Image size 2102x1736.
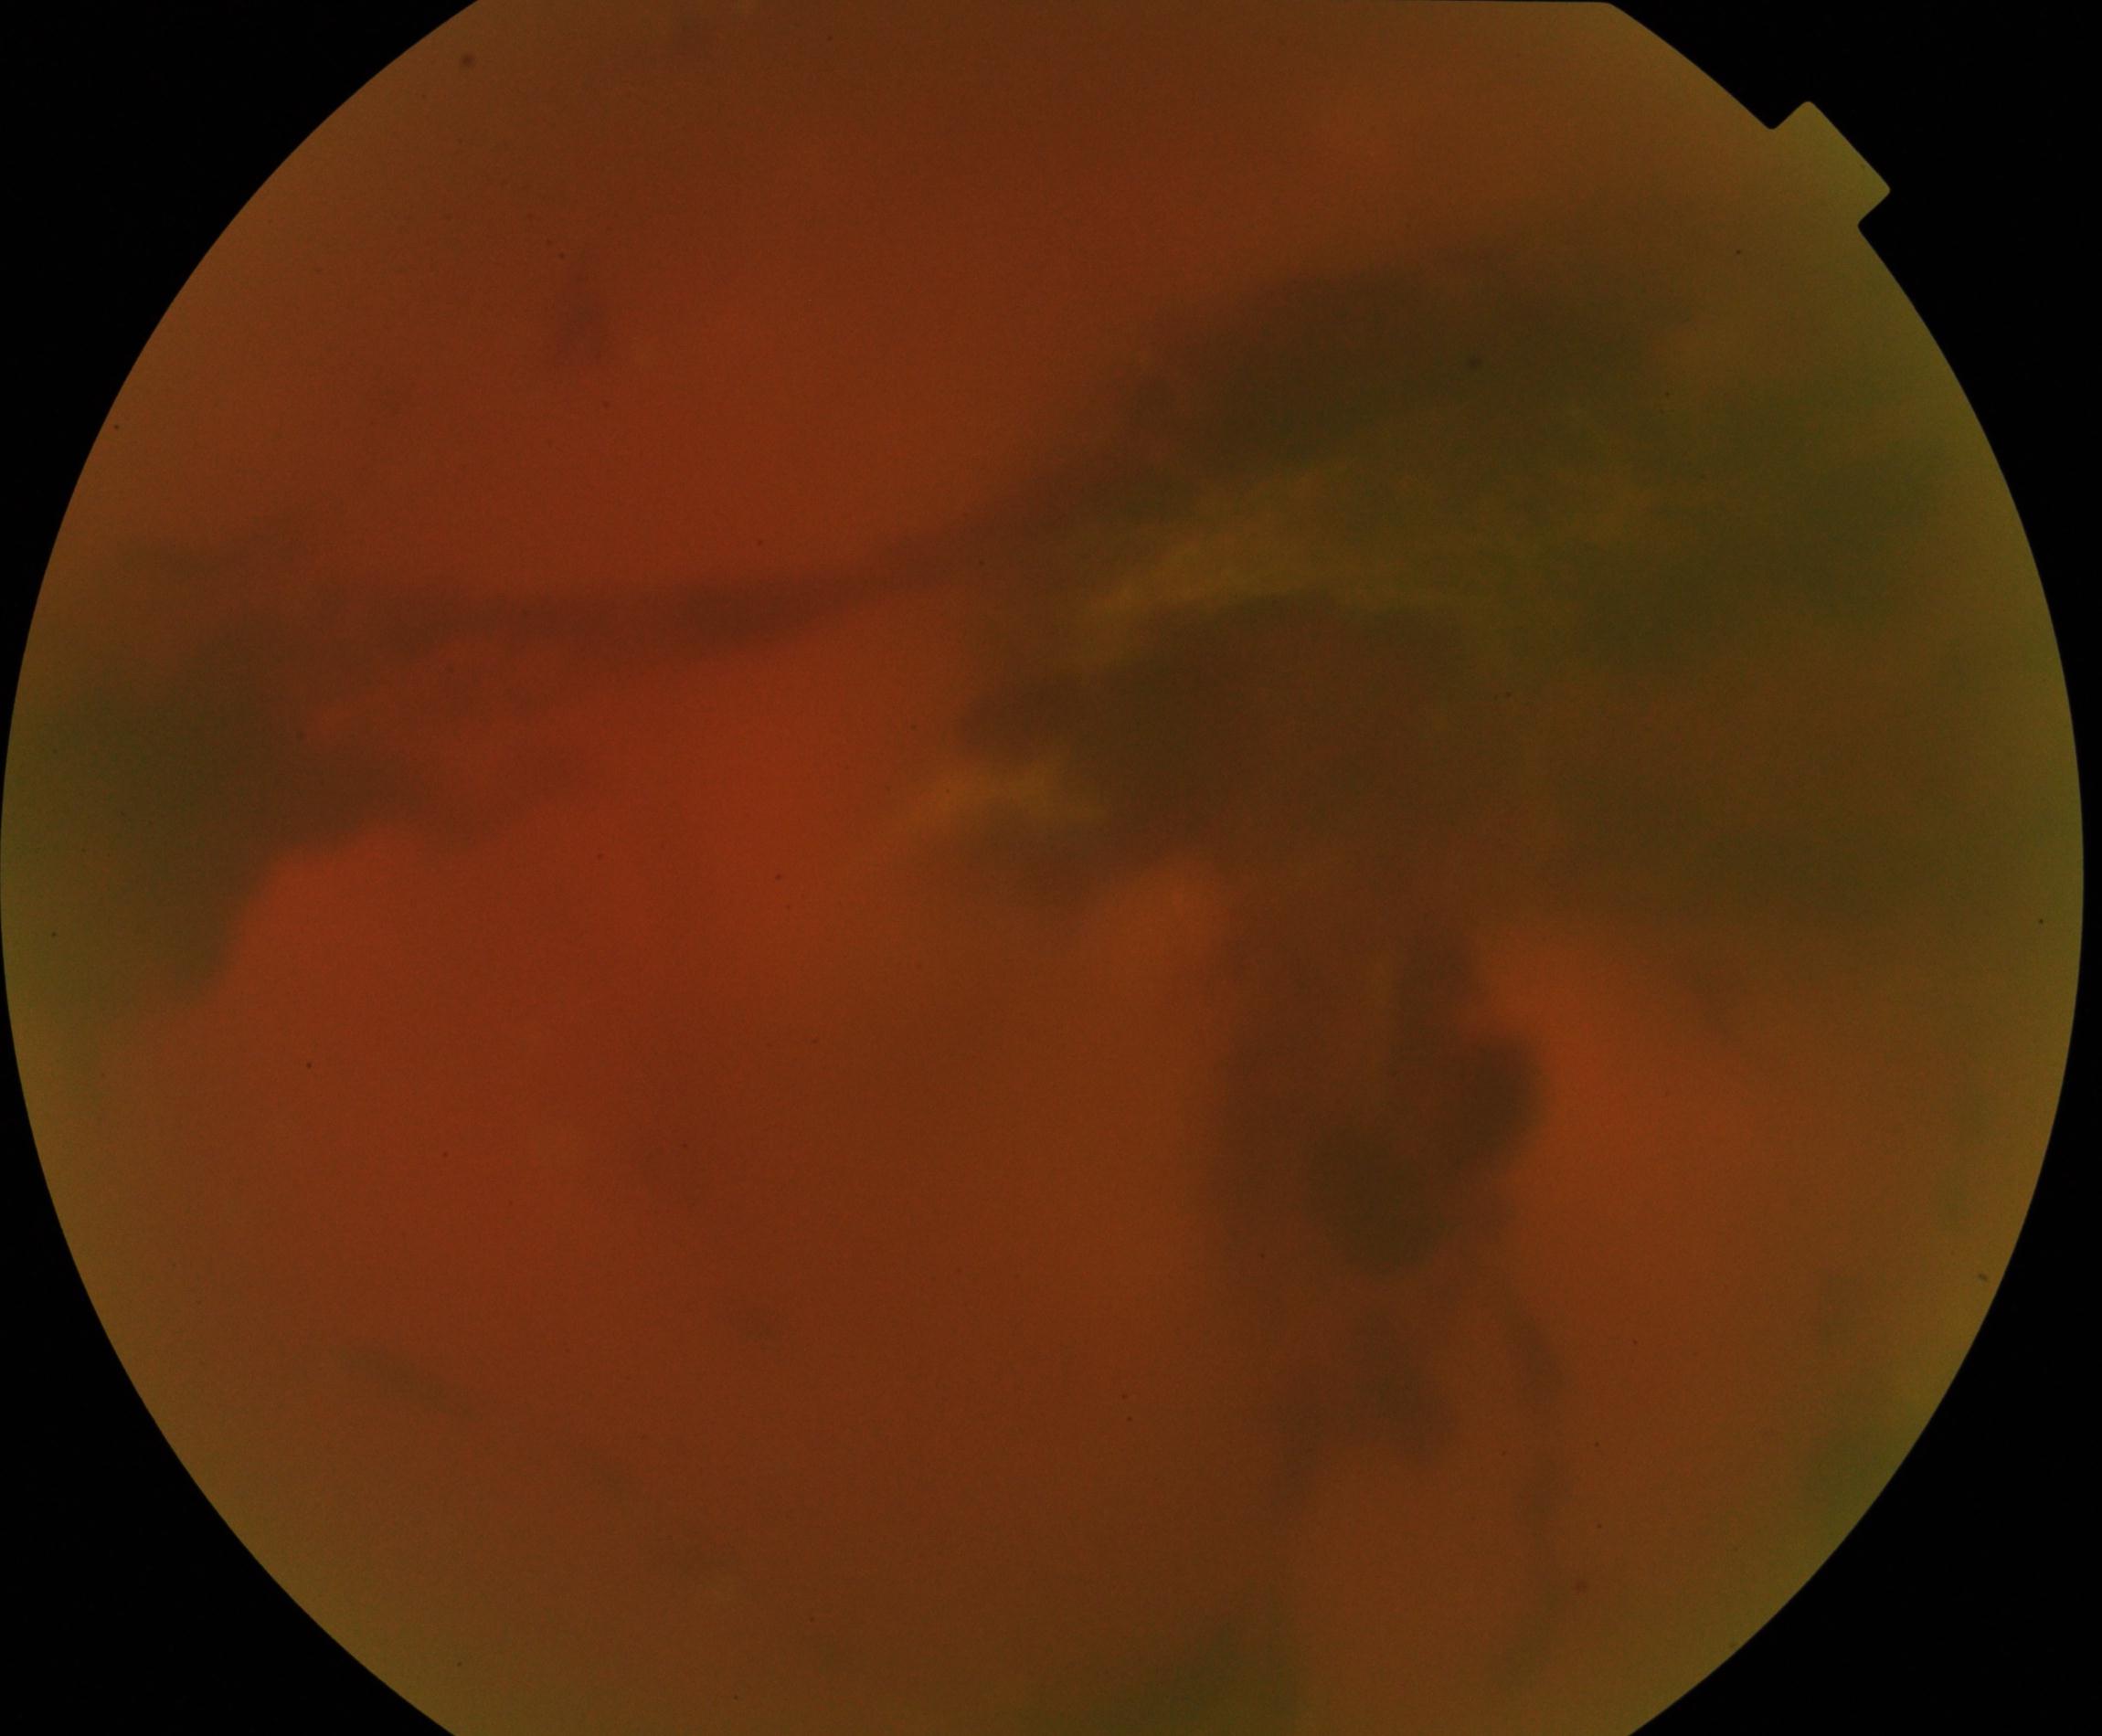
Poor-quality fundus photograph; retinal landmarks are largely obscured. Proliferative diabetic retinopathy is suspected.